Phoenix ICON wide-field infant fundus image · Phoenix ICON, 100° FOV — 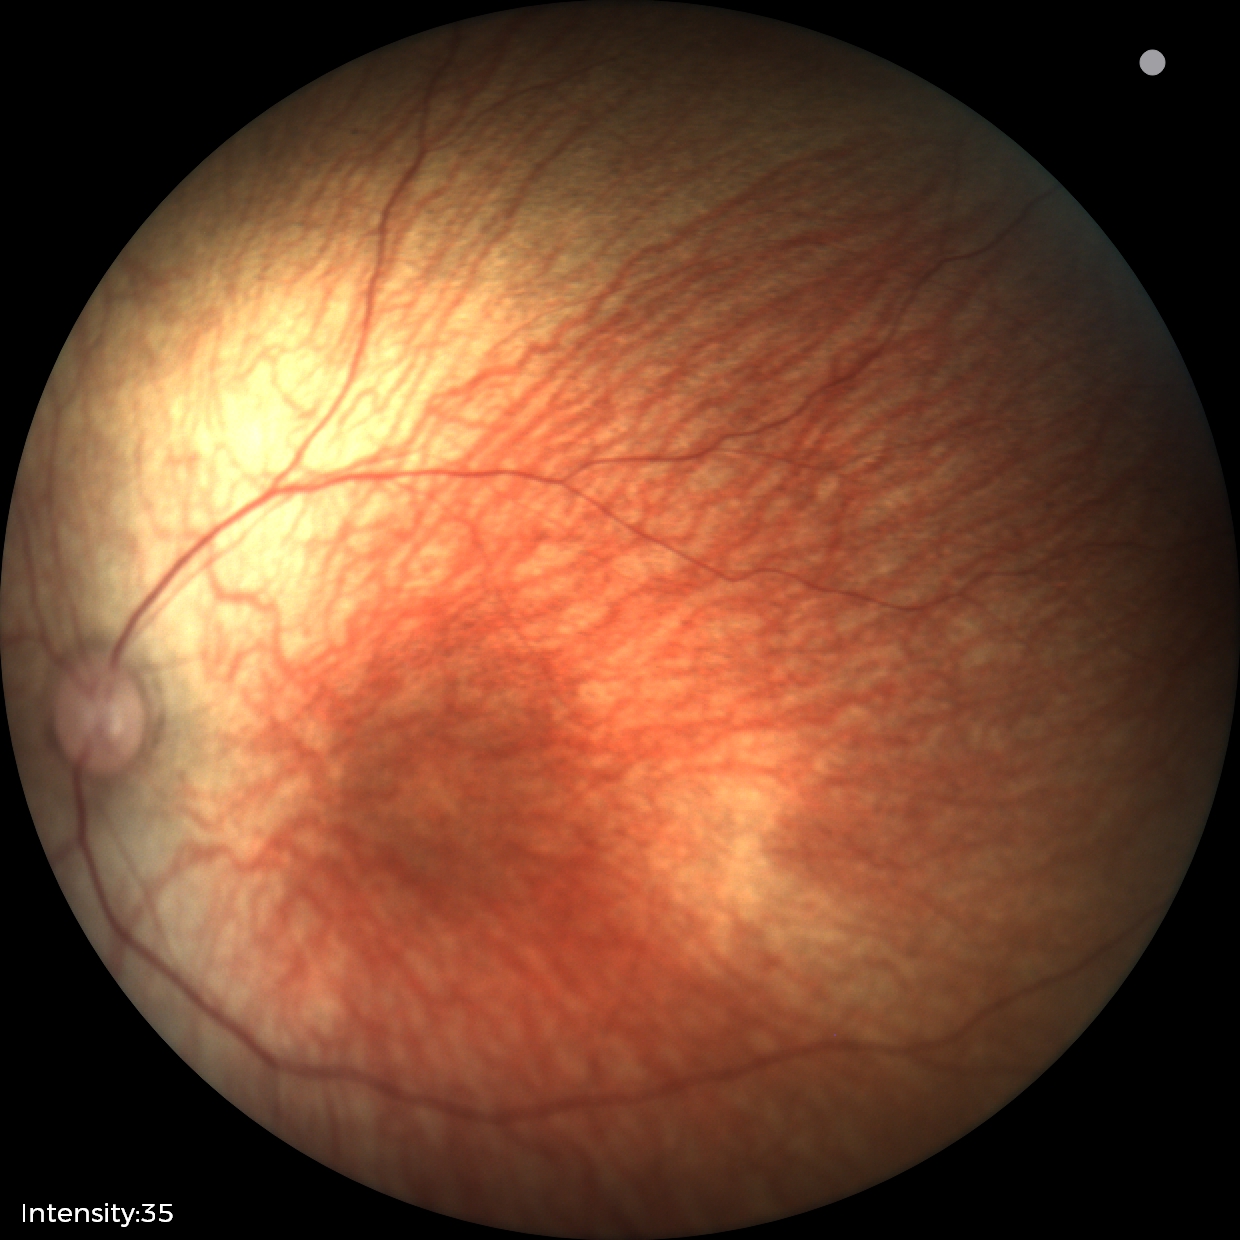
Normal screening examination.